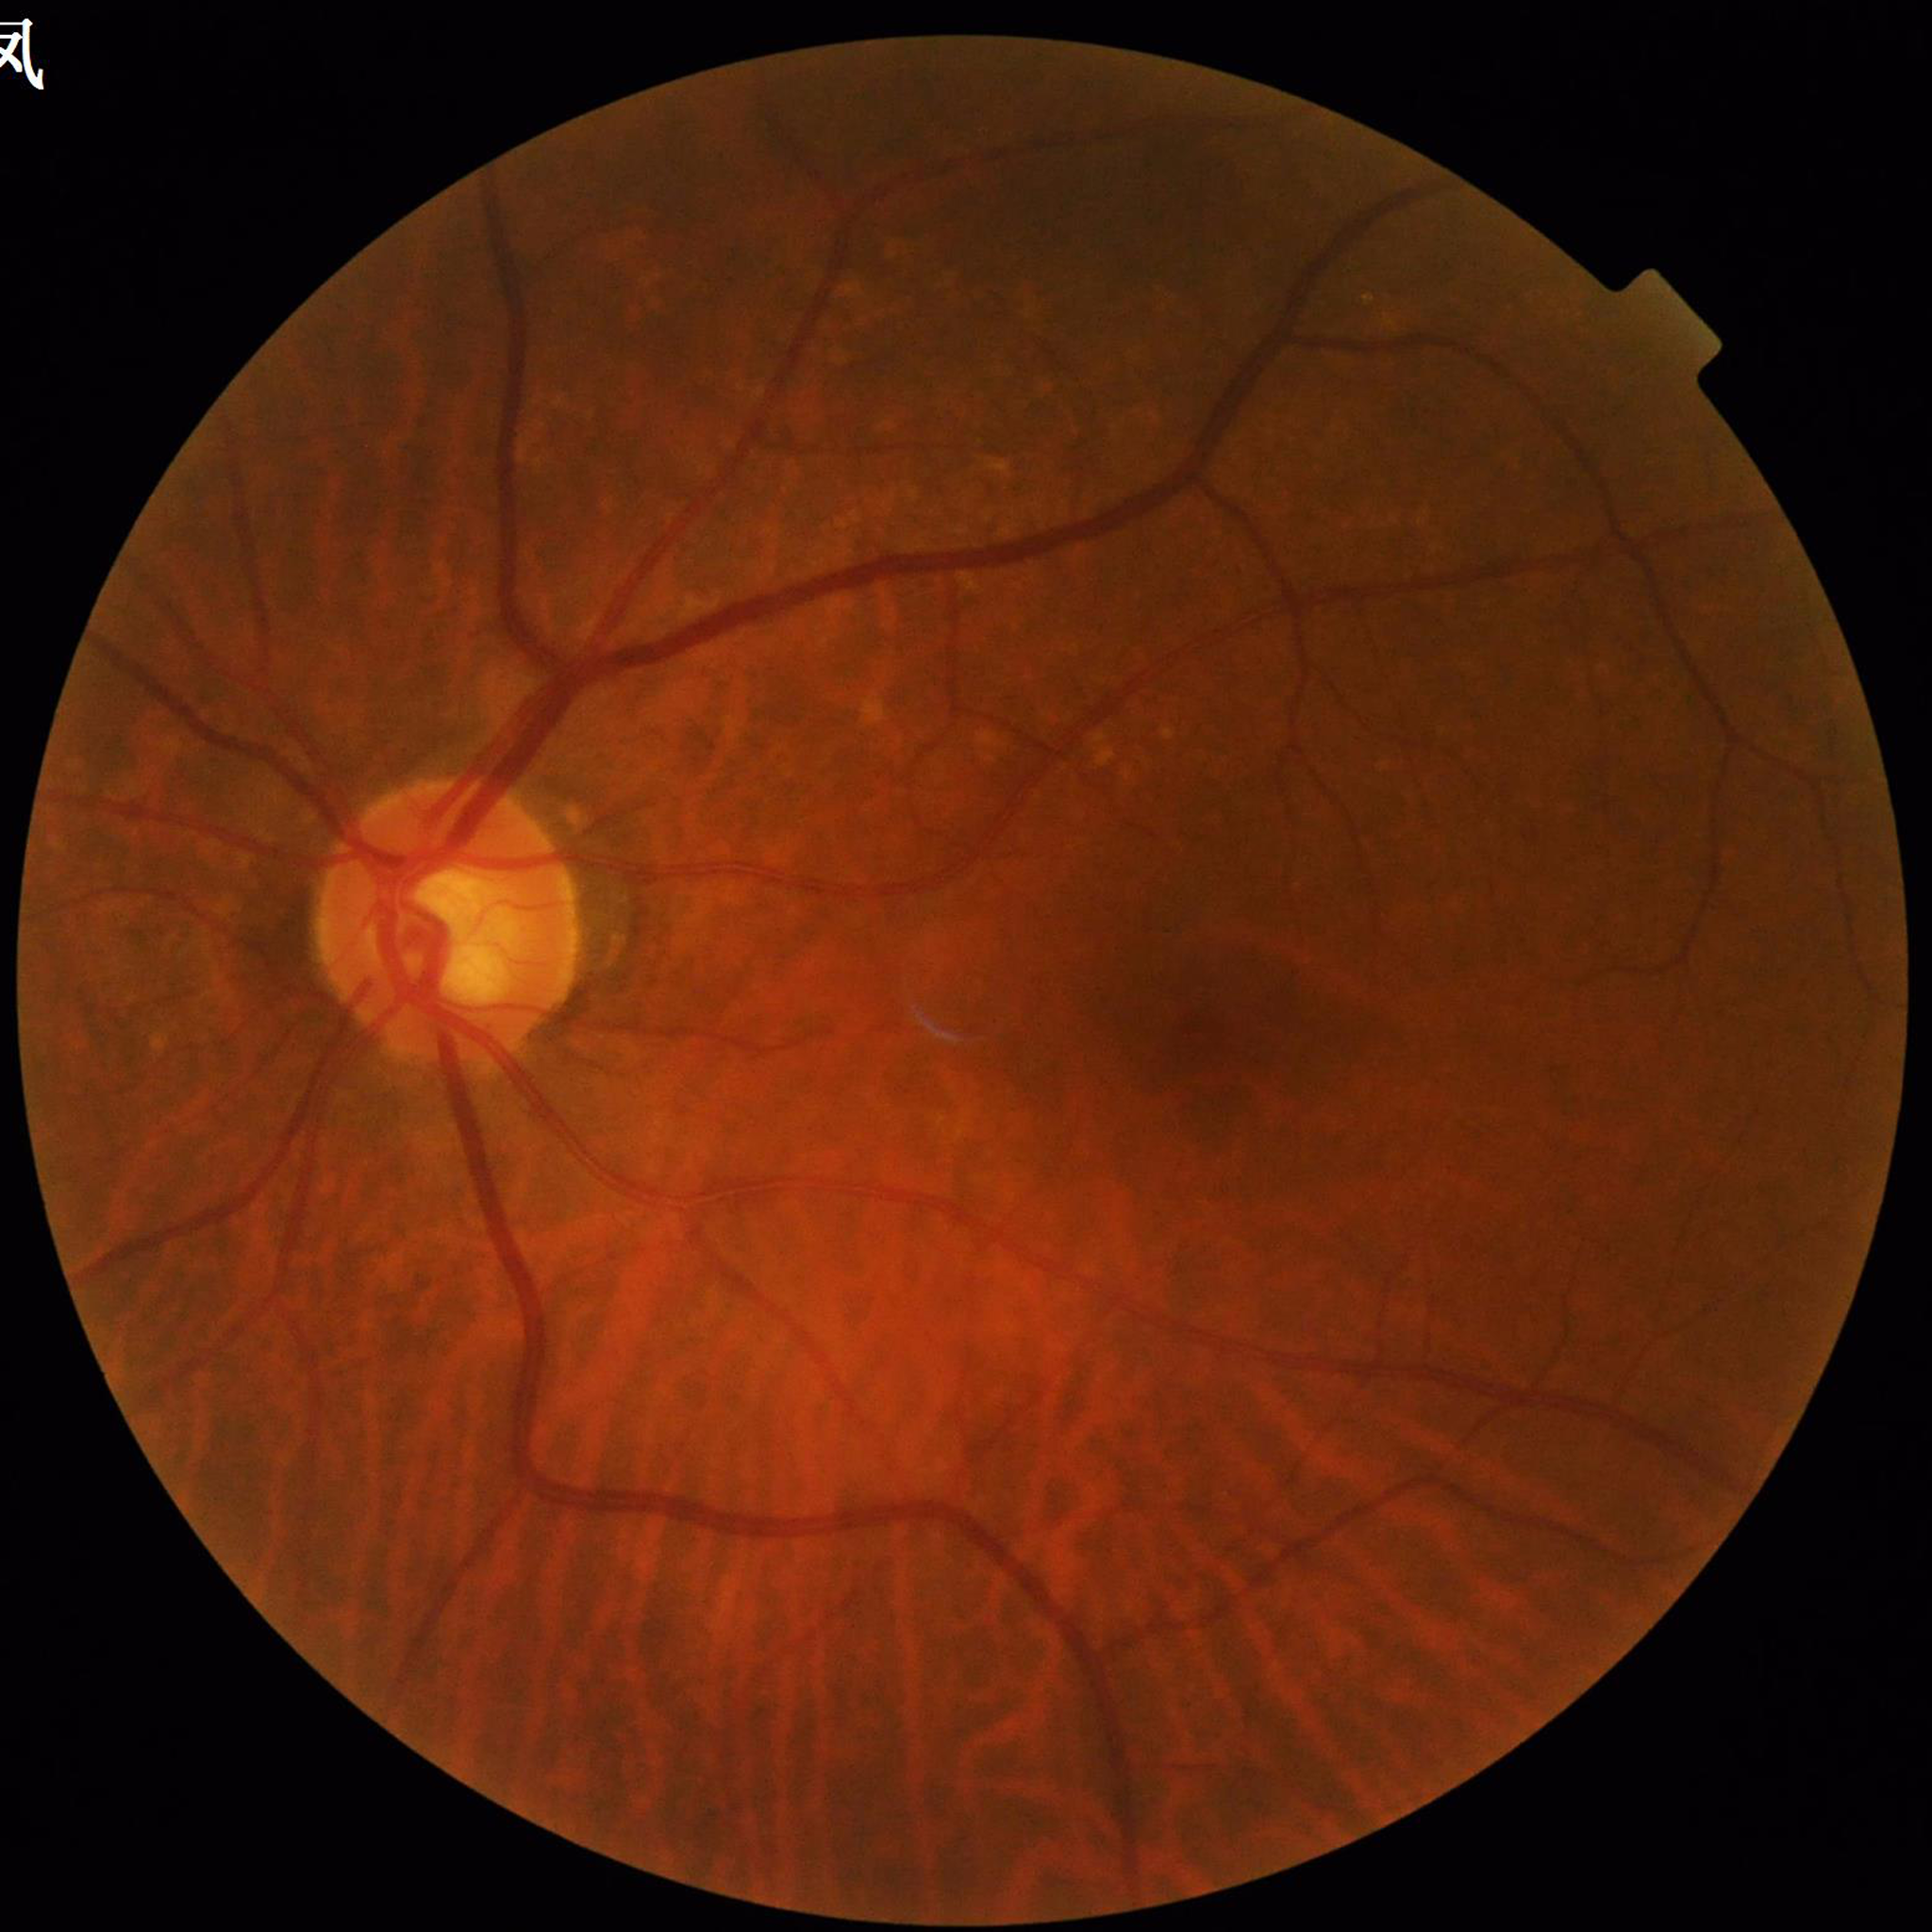 Fundus image of an eye with DR.